45° field of view — 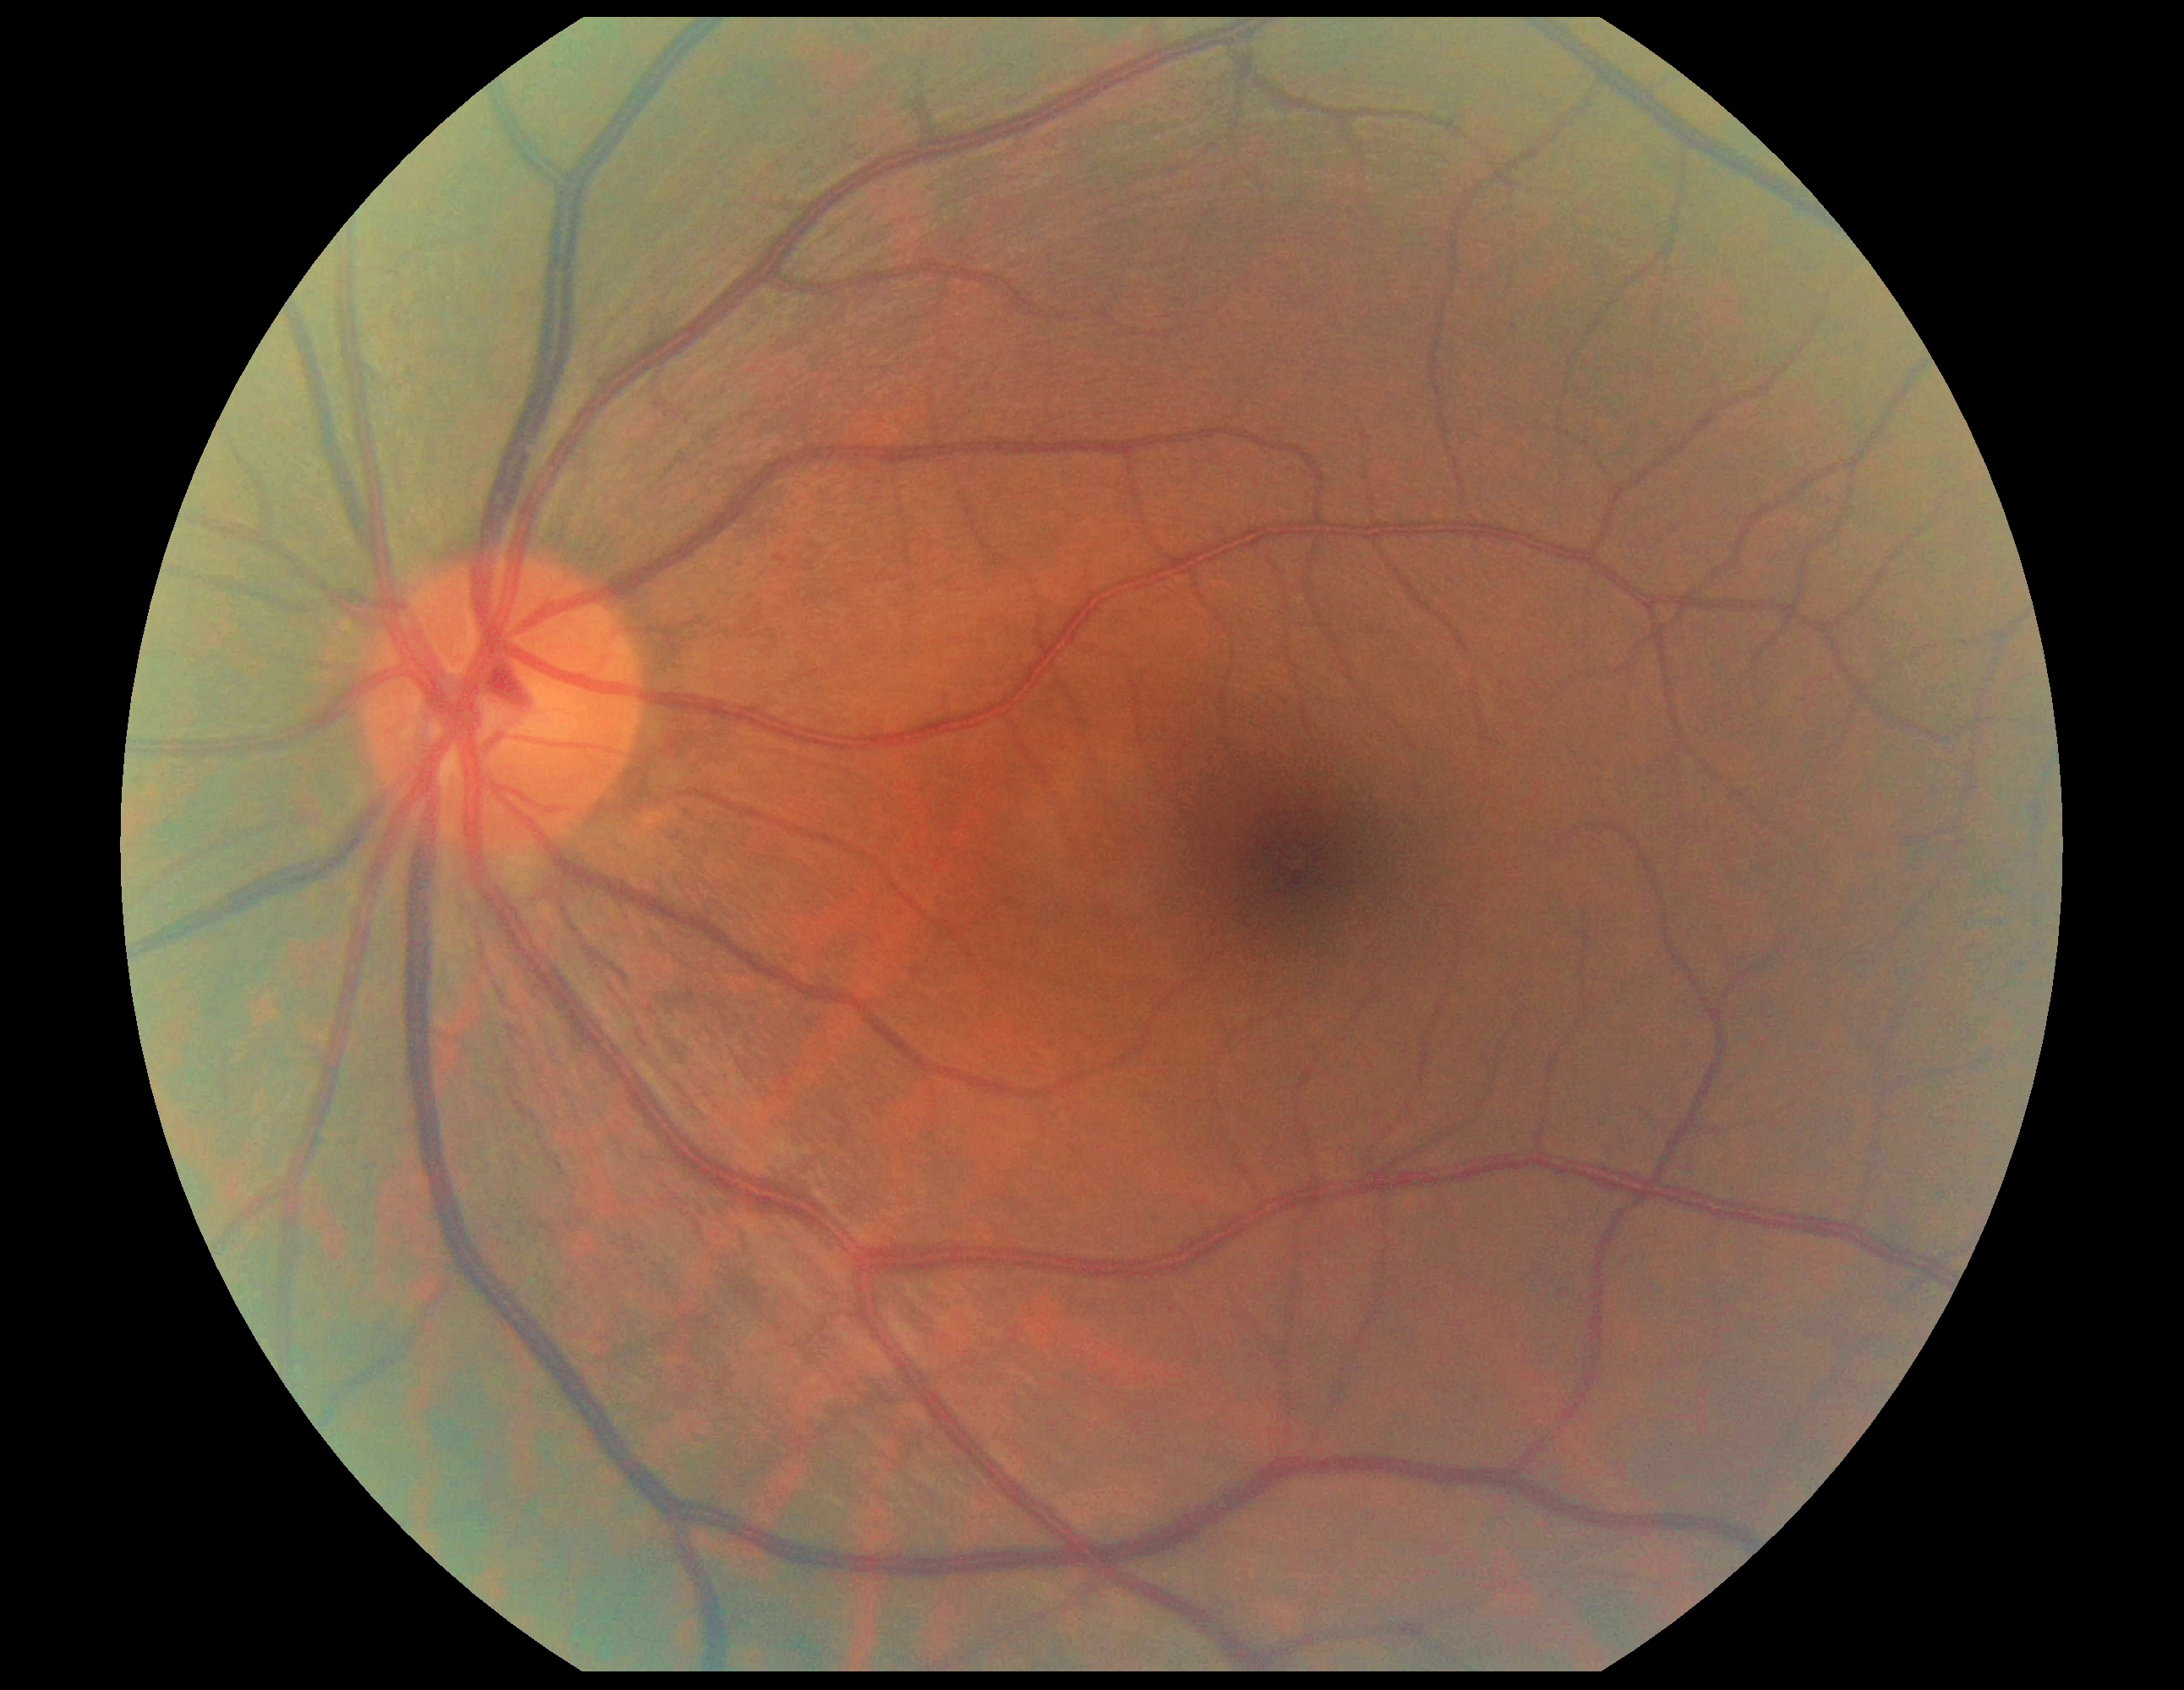 DR stage@0.